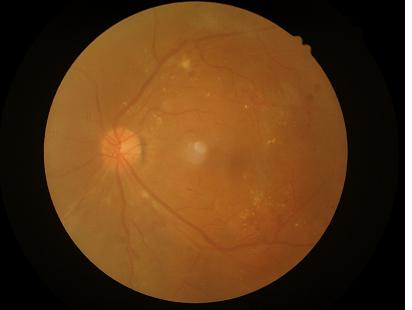
Overall image quality: good and suitable for diagnostic use | Focus: sharp throughout the field | Illumination/color: even and well-balanced | Contrast: vessels and details readily distinguishable.